Davis DR grading.
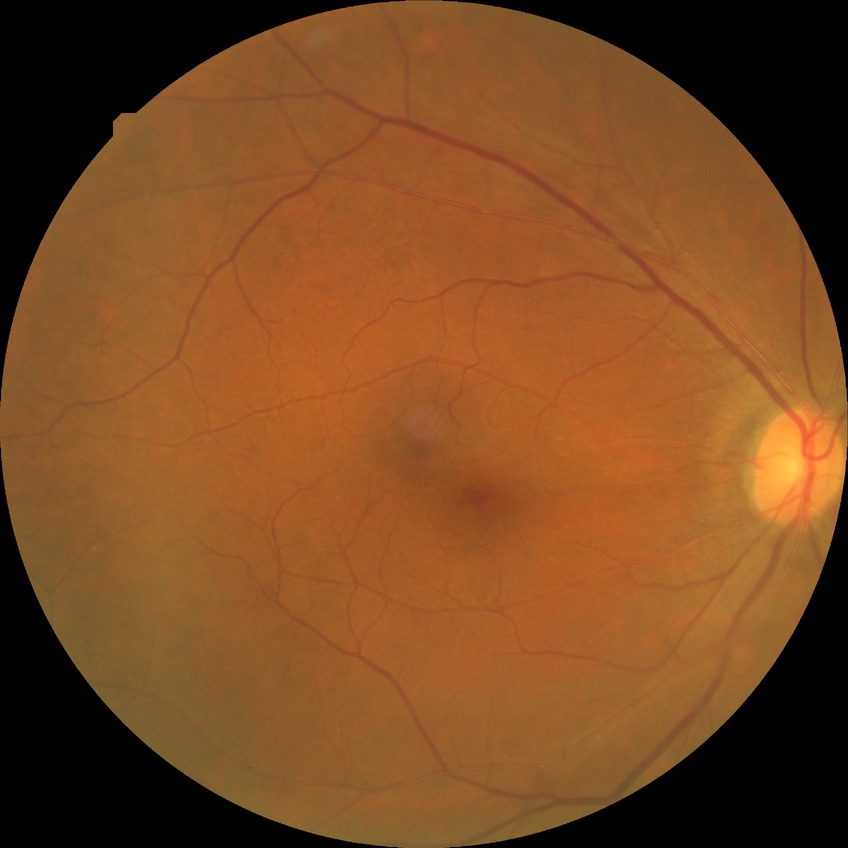

Diabetic retinopathy (DR): simple diabetic retinopathy (SDR).